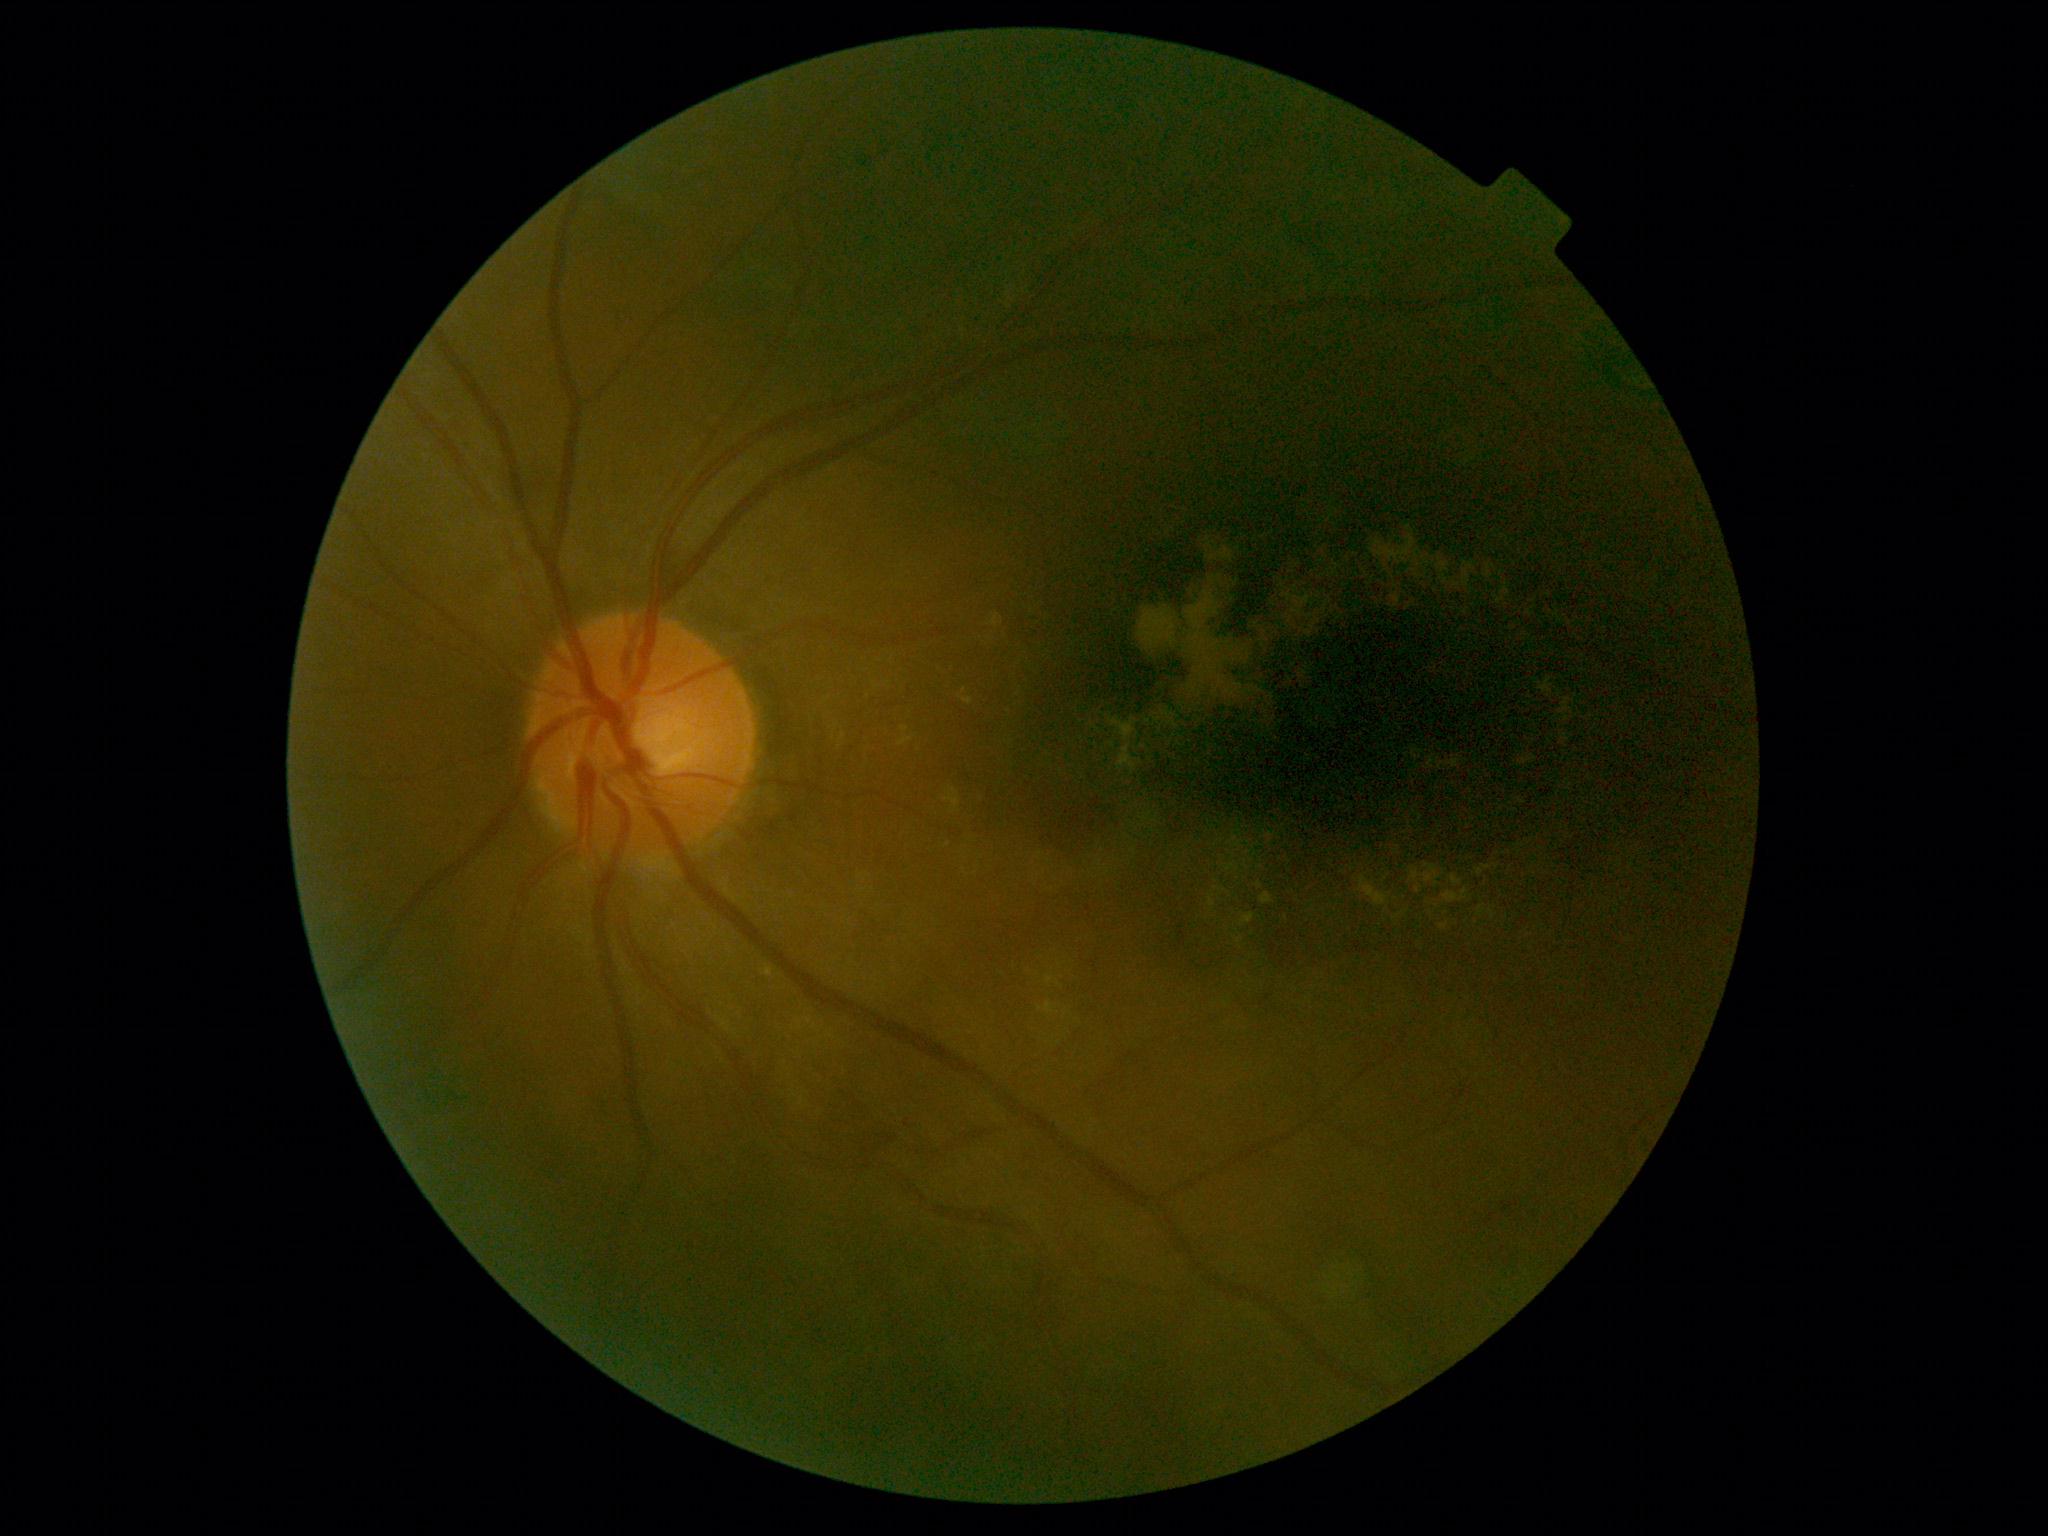 * diabetic retinopathy (DR) — grade 2 (moderate NPDR) — more than just microaneurysms but less than severe NPDR